RetCam wide-field infant fundus image. Camera: Clarity RetCam 3 (130° FOV): 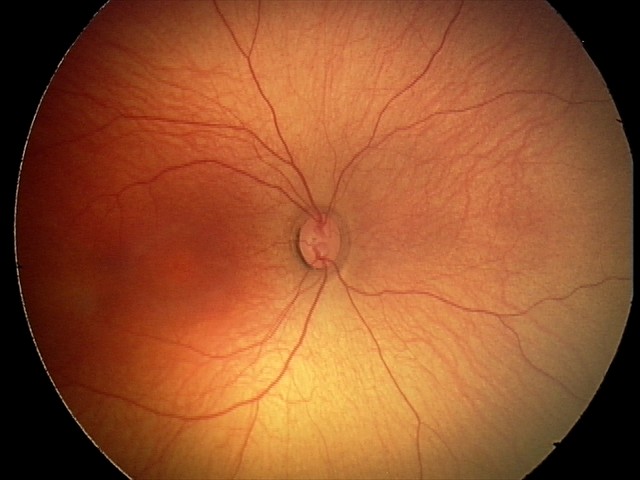

Examination with physiological retinal findings.